640x480. Wide-field contact fundus photograph of an infant
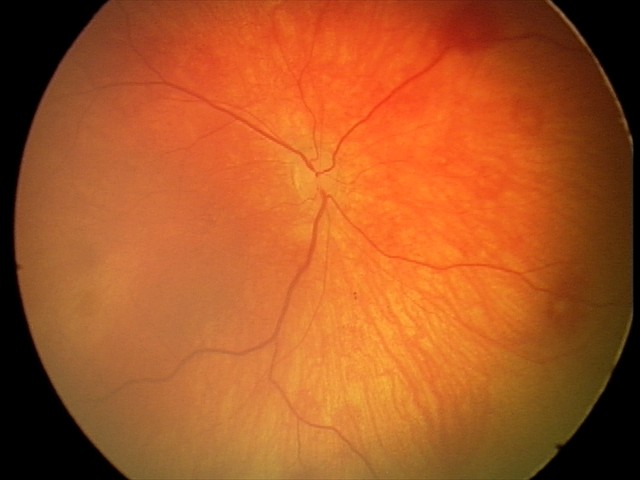 Screening examination with no abnormal retinal findings.